Camera: Clarity RetCam 3 (130° FOV); 640x480px; wide-field fundus image from infant ROP screening — 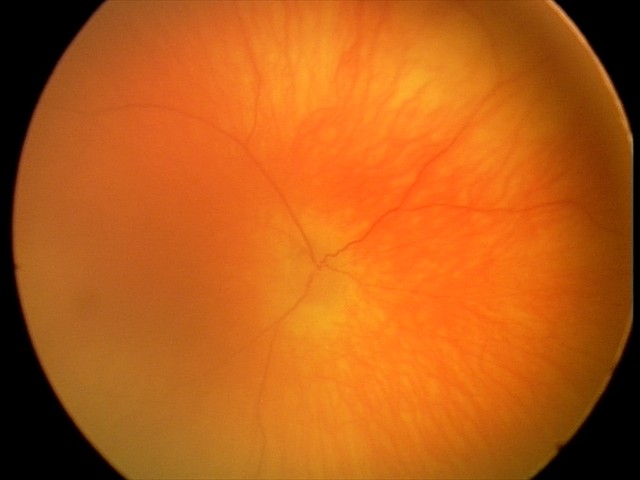 Screening examination with no abnormal retinal findings.